Wide-field fundus photograph of an infant: 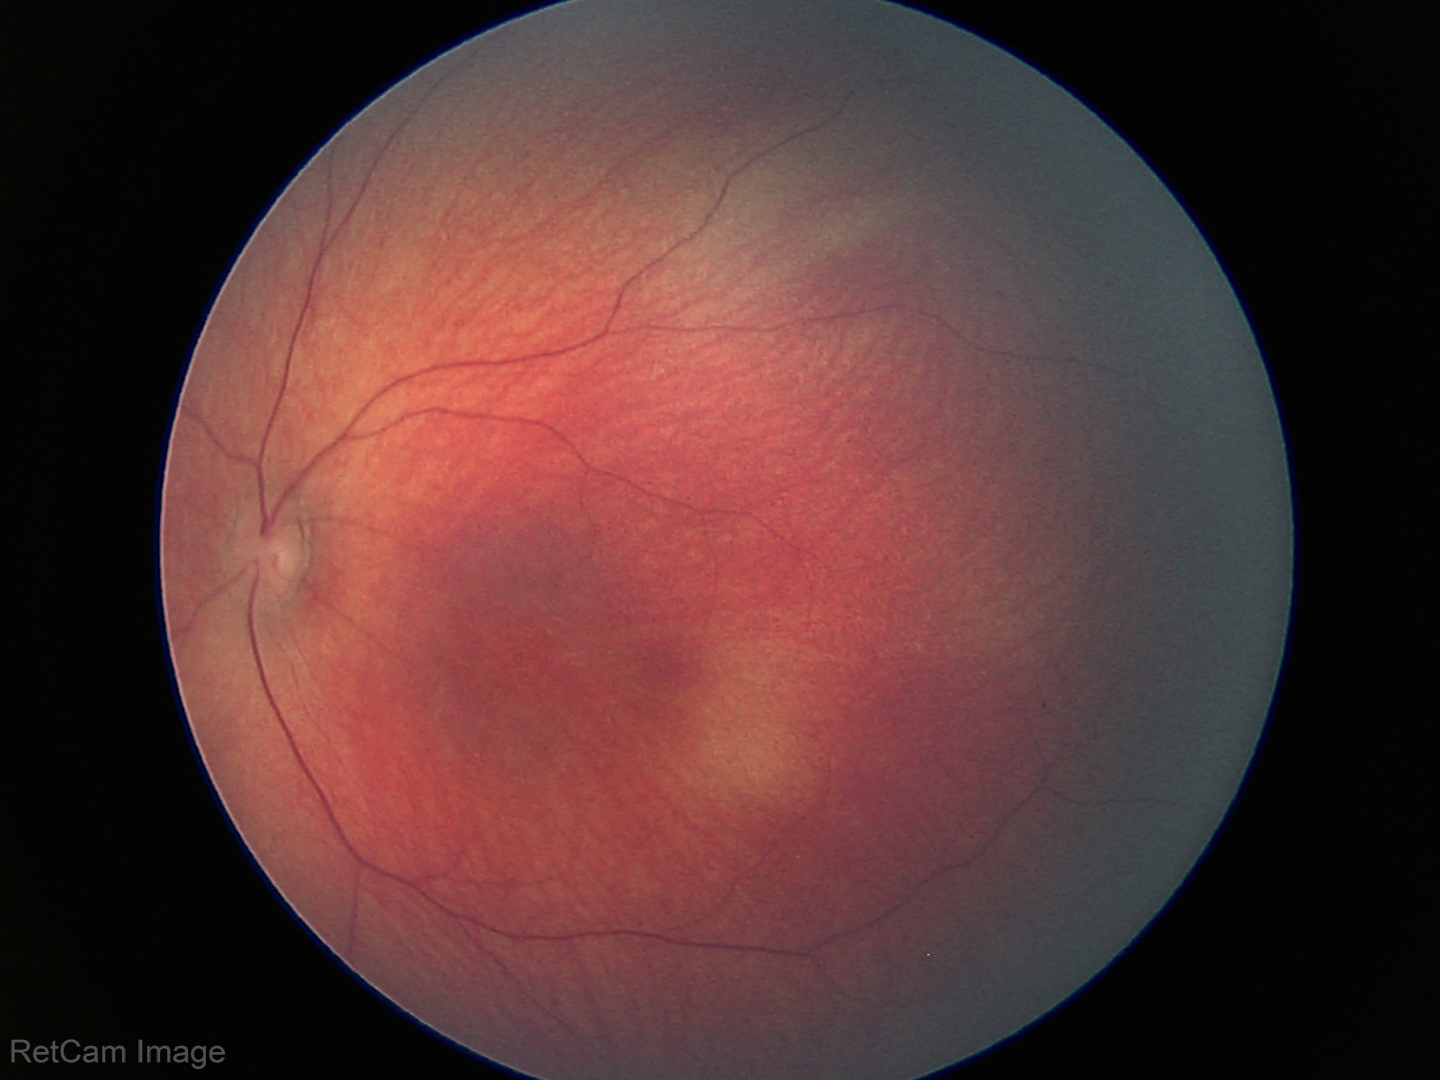 Screening examination with no abnormal retinal findings.